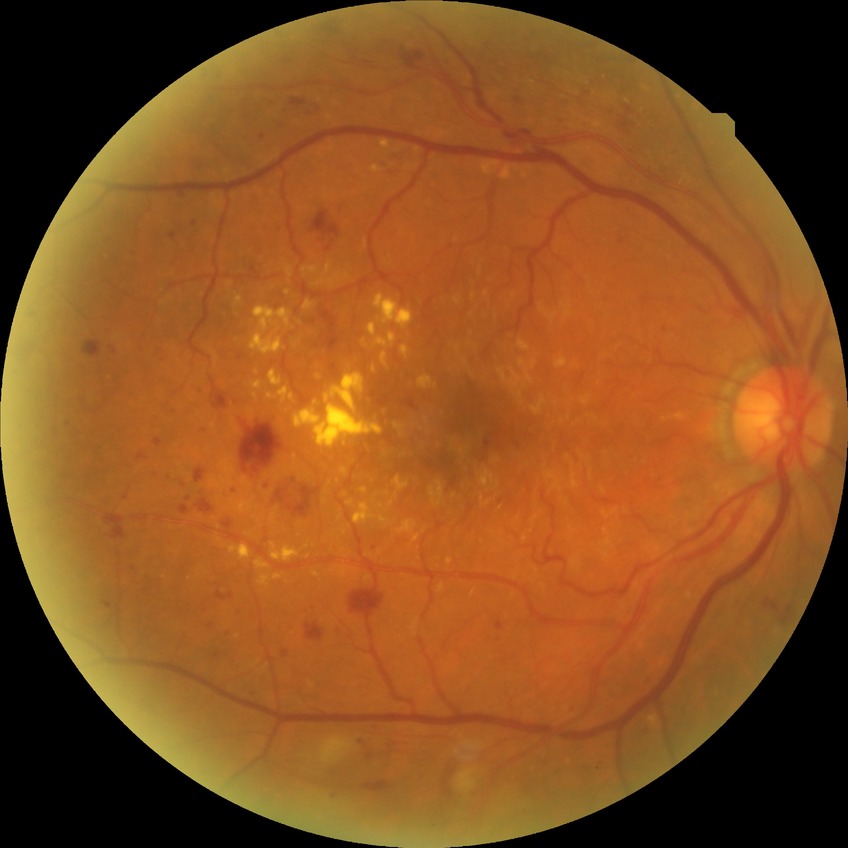
DR severity is PPDR.